848x848, CFP, camera: NIDEK AFC-230, nonmydriatic
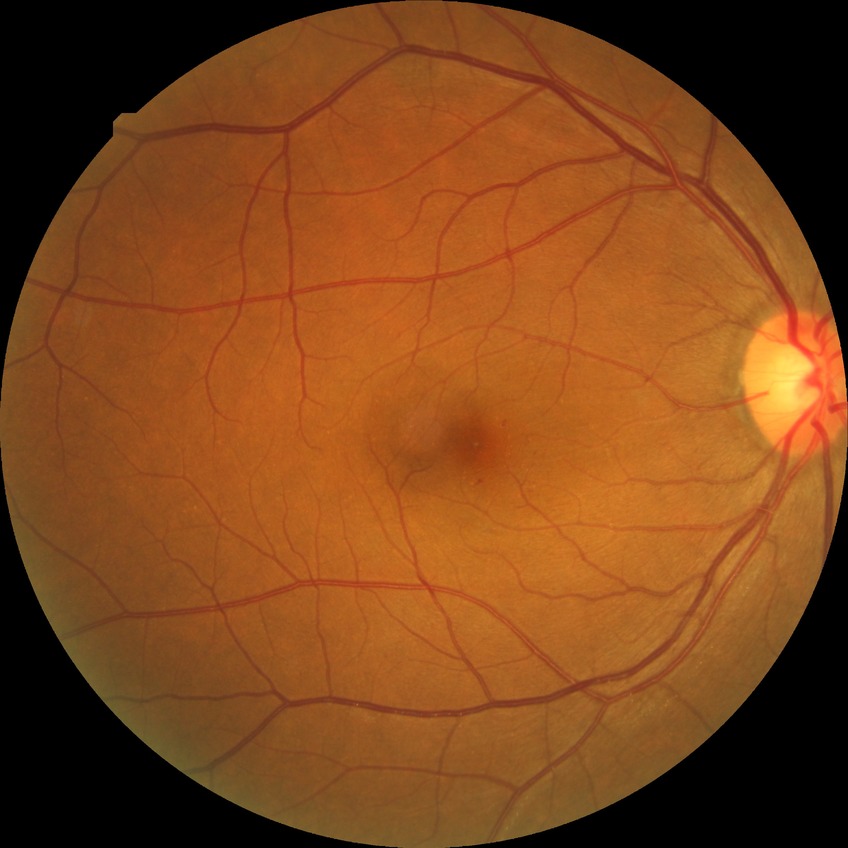 DR grade = SDR.